Wide-field fundus image from infant ROP screening; 130° field of view (Natus RetCam Envision):
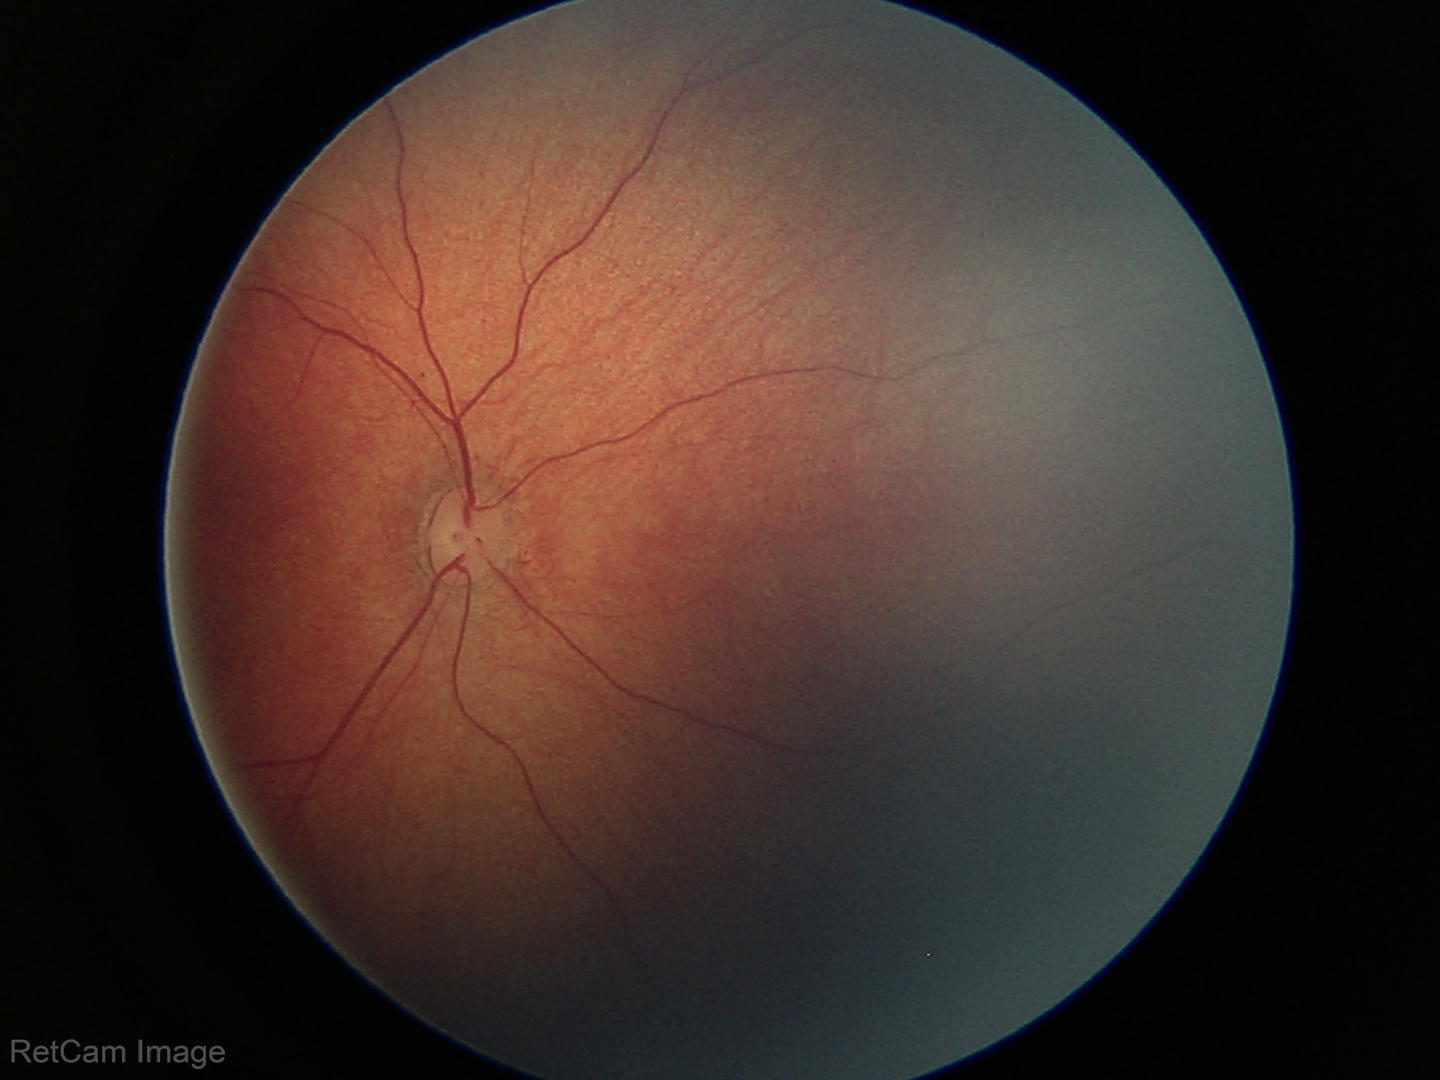 Screening examination with no abnormal retinal findings.